2352x1568px · color fundus image
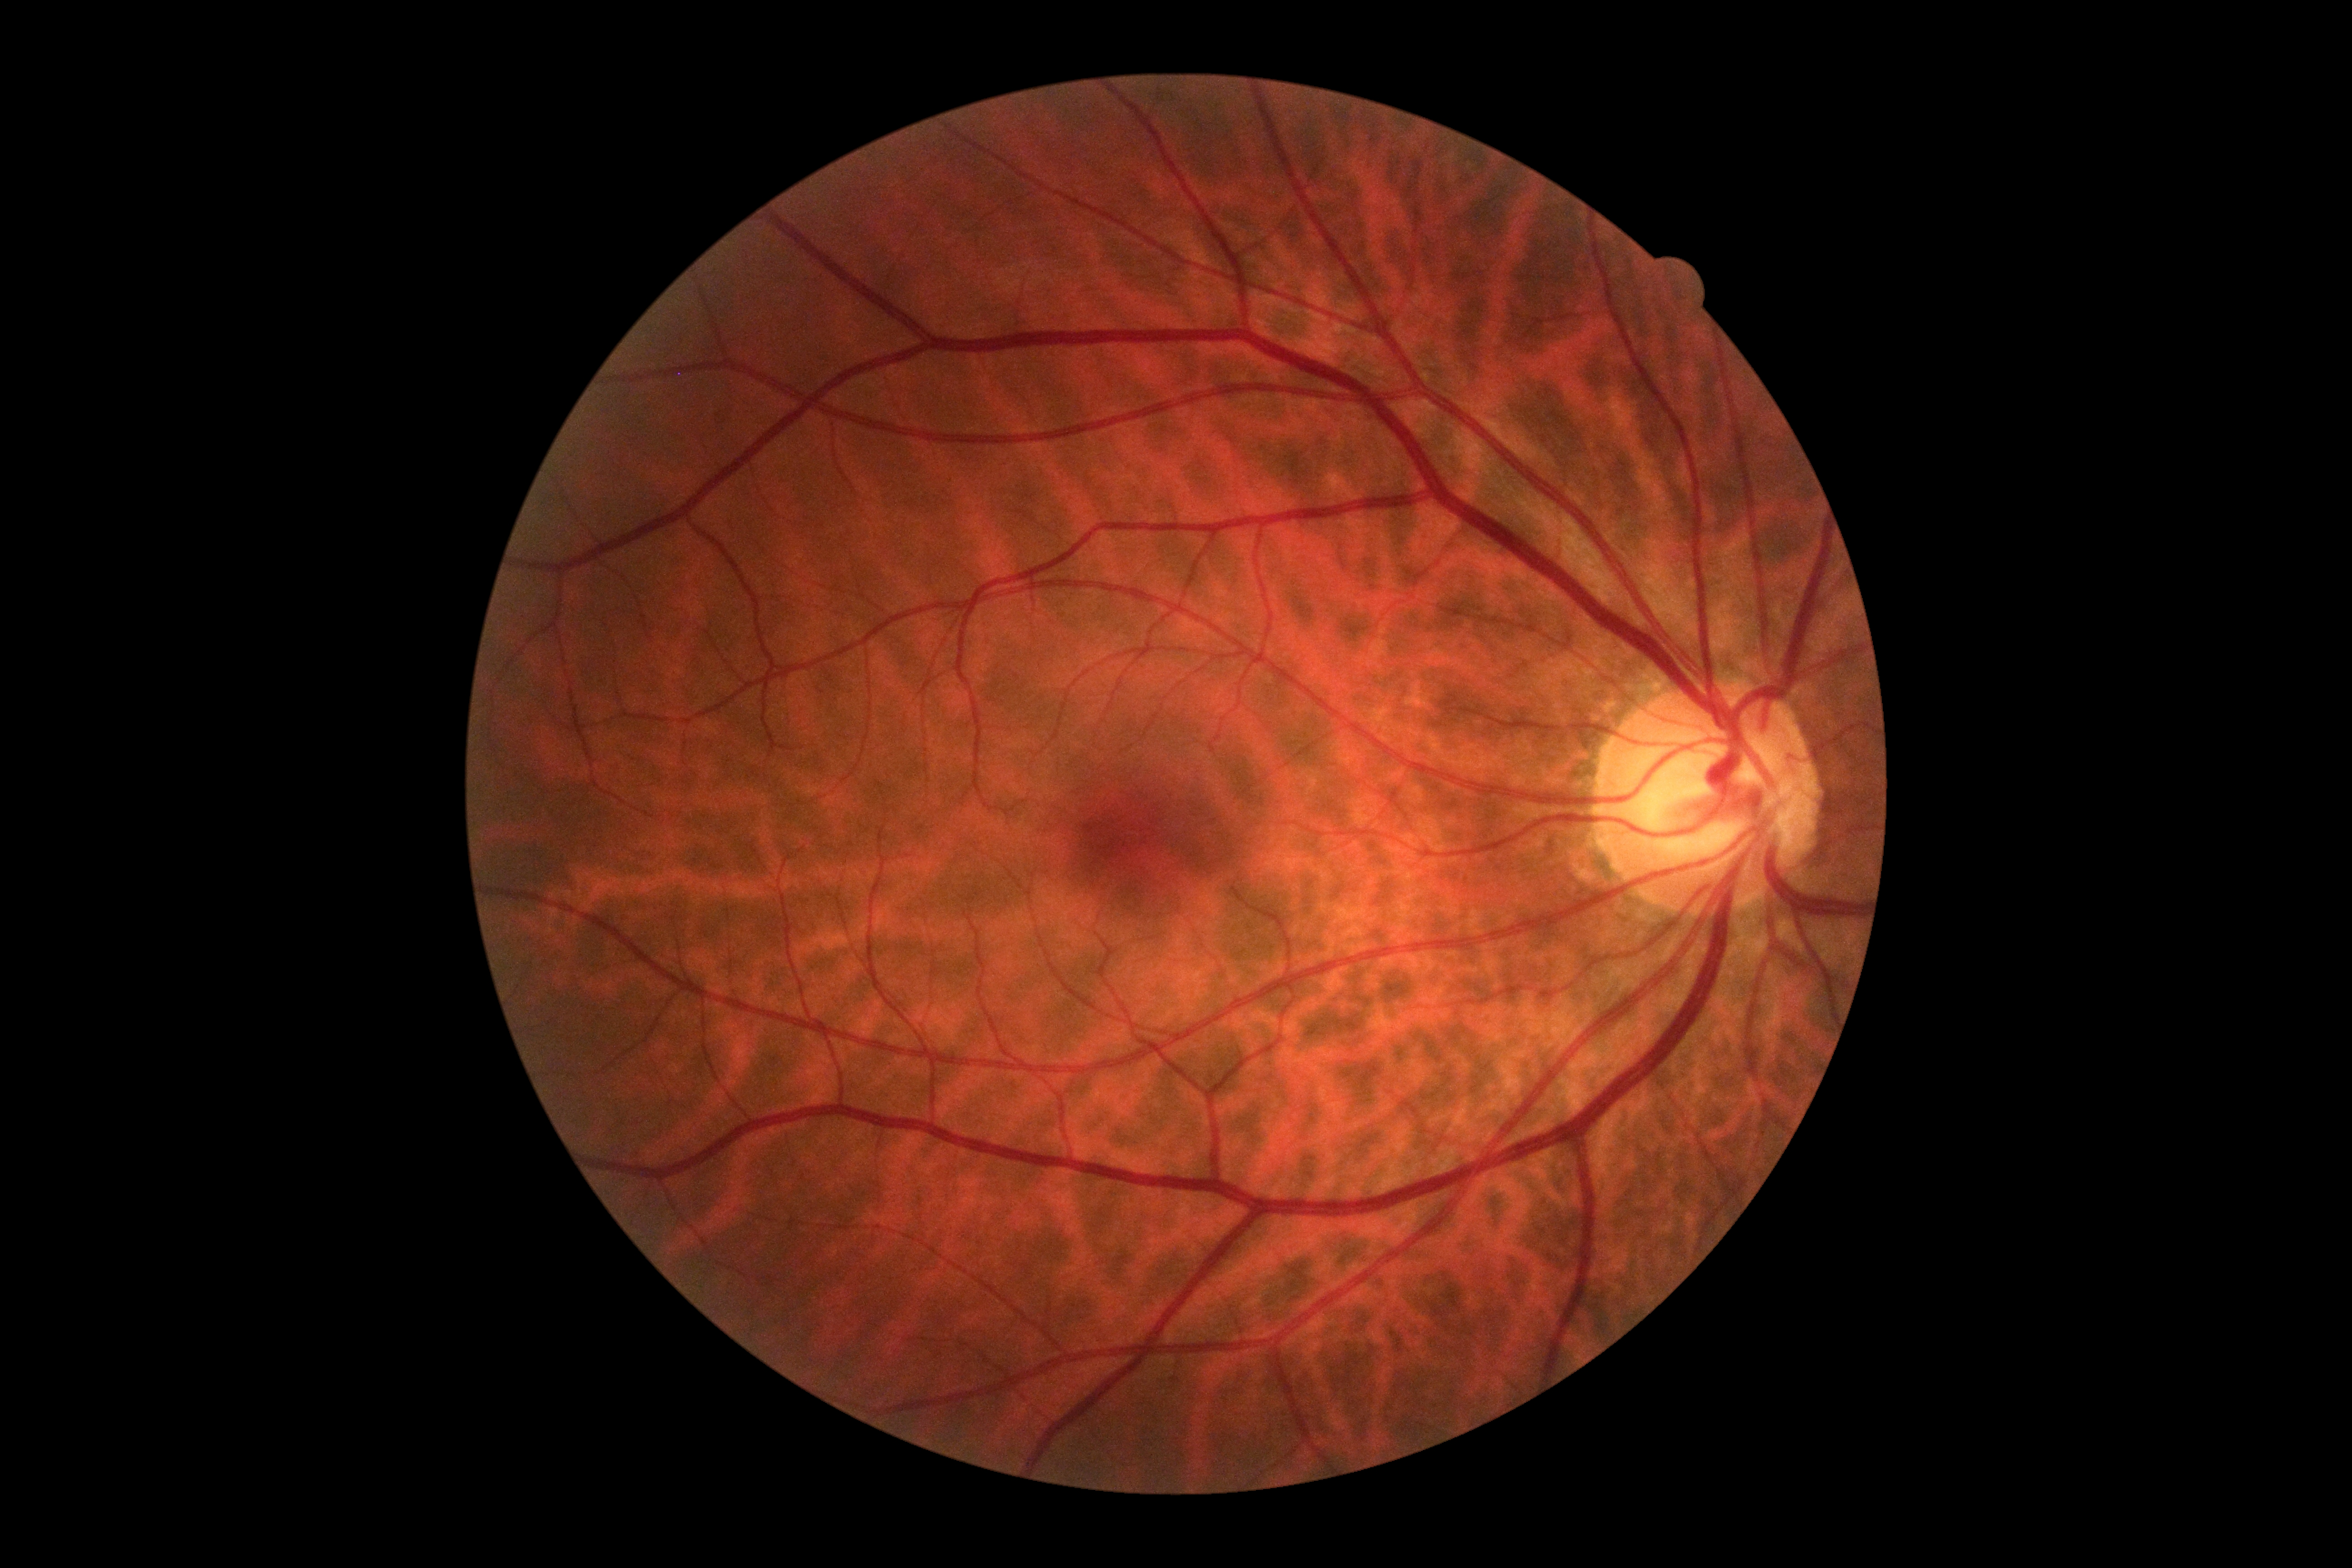

DR impression = no signs of DR, diabetic retinopathy (DR) = grade 0 (no apparent retinopathy).